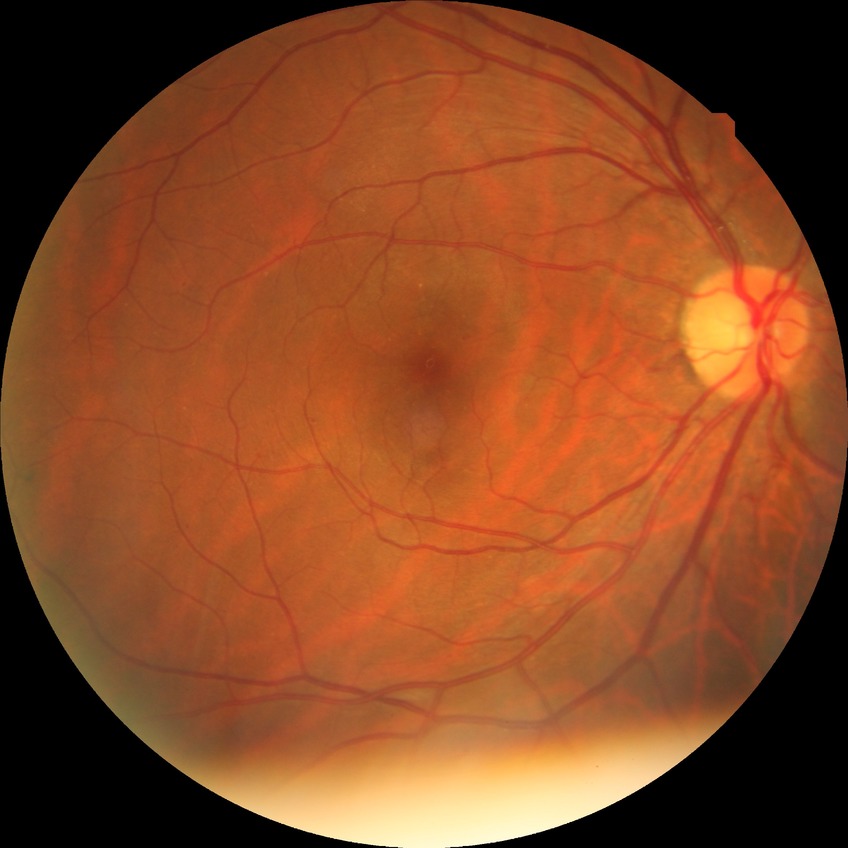

Diabetic retinopathy severity is simple diabetic retinopathy.